45-degree field of view · fundus photo
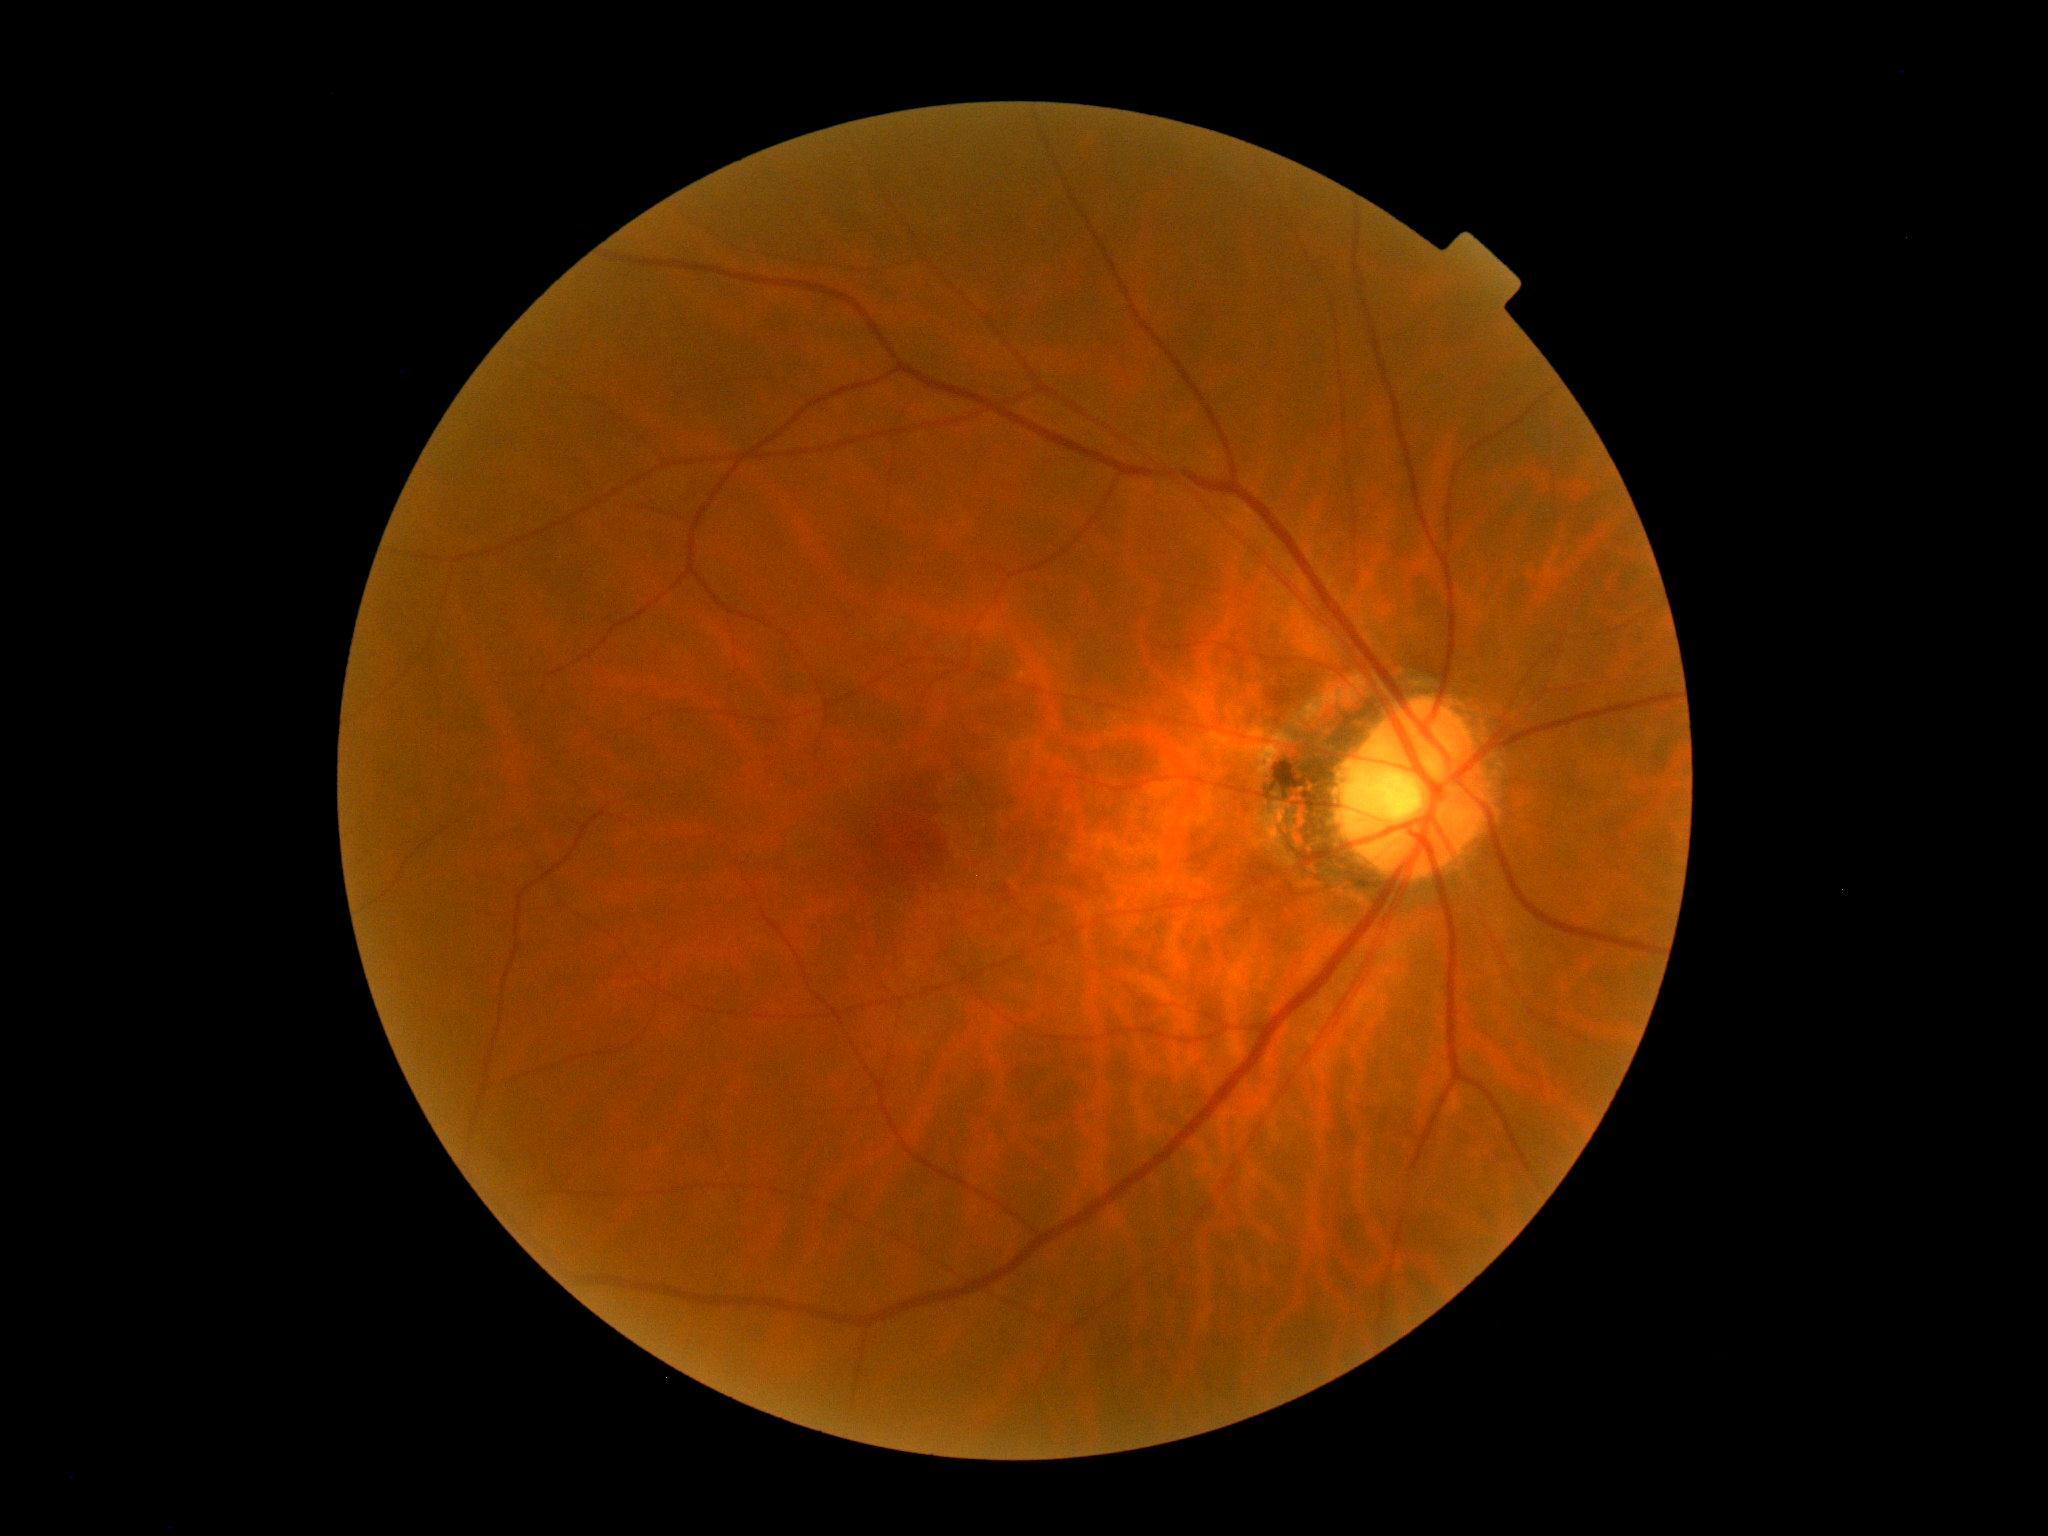 DR stage is no apparent retinopathy (grade 0).